Image size 1240x1240 · infant wide-field fundus photograph:
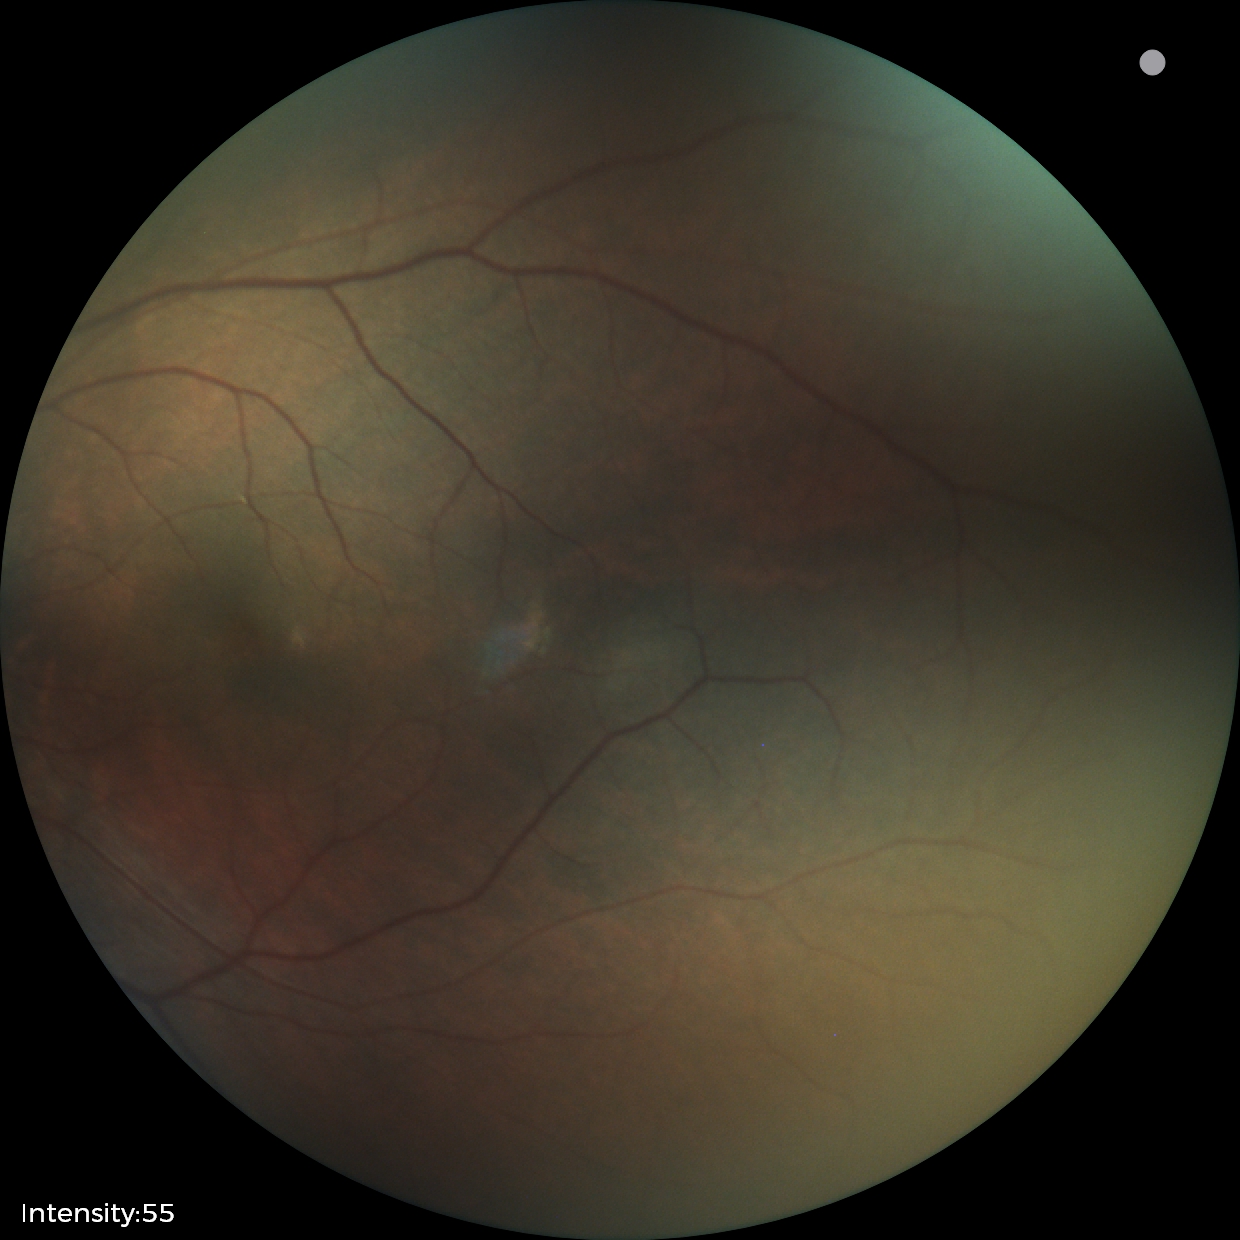

Screening: no abnormal retinal findings.